848 by 848 pixels · camera: NIDEK AFC-230 · 45-degree field of view · Davis DR grading · no pharmacologic dilation: 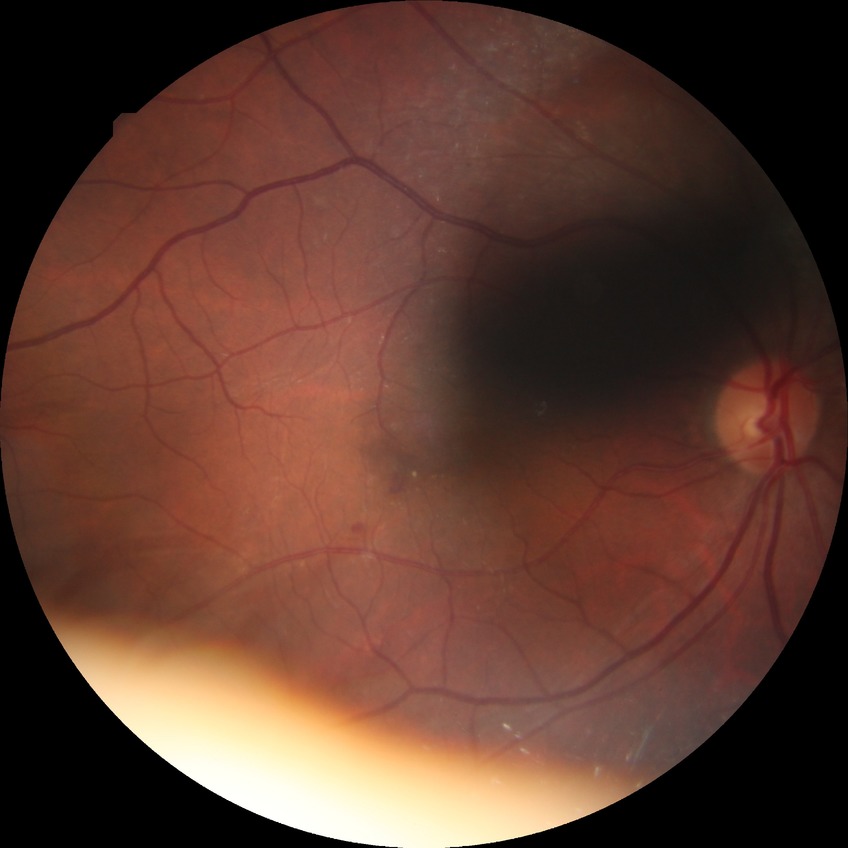 Diabetic retinopathy (DR): SDR (simple diabetic retinopathy). DR class: non-proliferative diabetic retinopathy.